Optic disc region crop · acquired with a Nidek AFC-330:
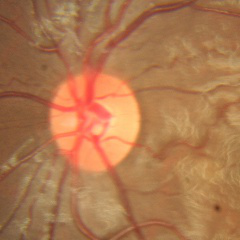 The image shows no glaucomatous optic neuropathy.